Camera: Phoenix ICON (100° FOV) · 1240 by 1240 pixels · Phoenix ICON wide-field infant fundus image:
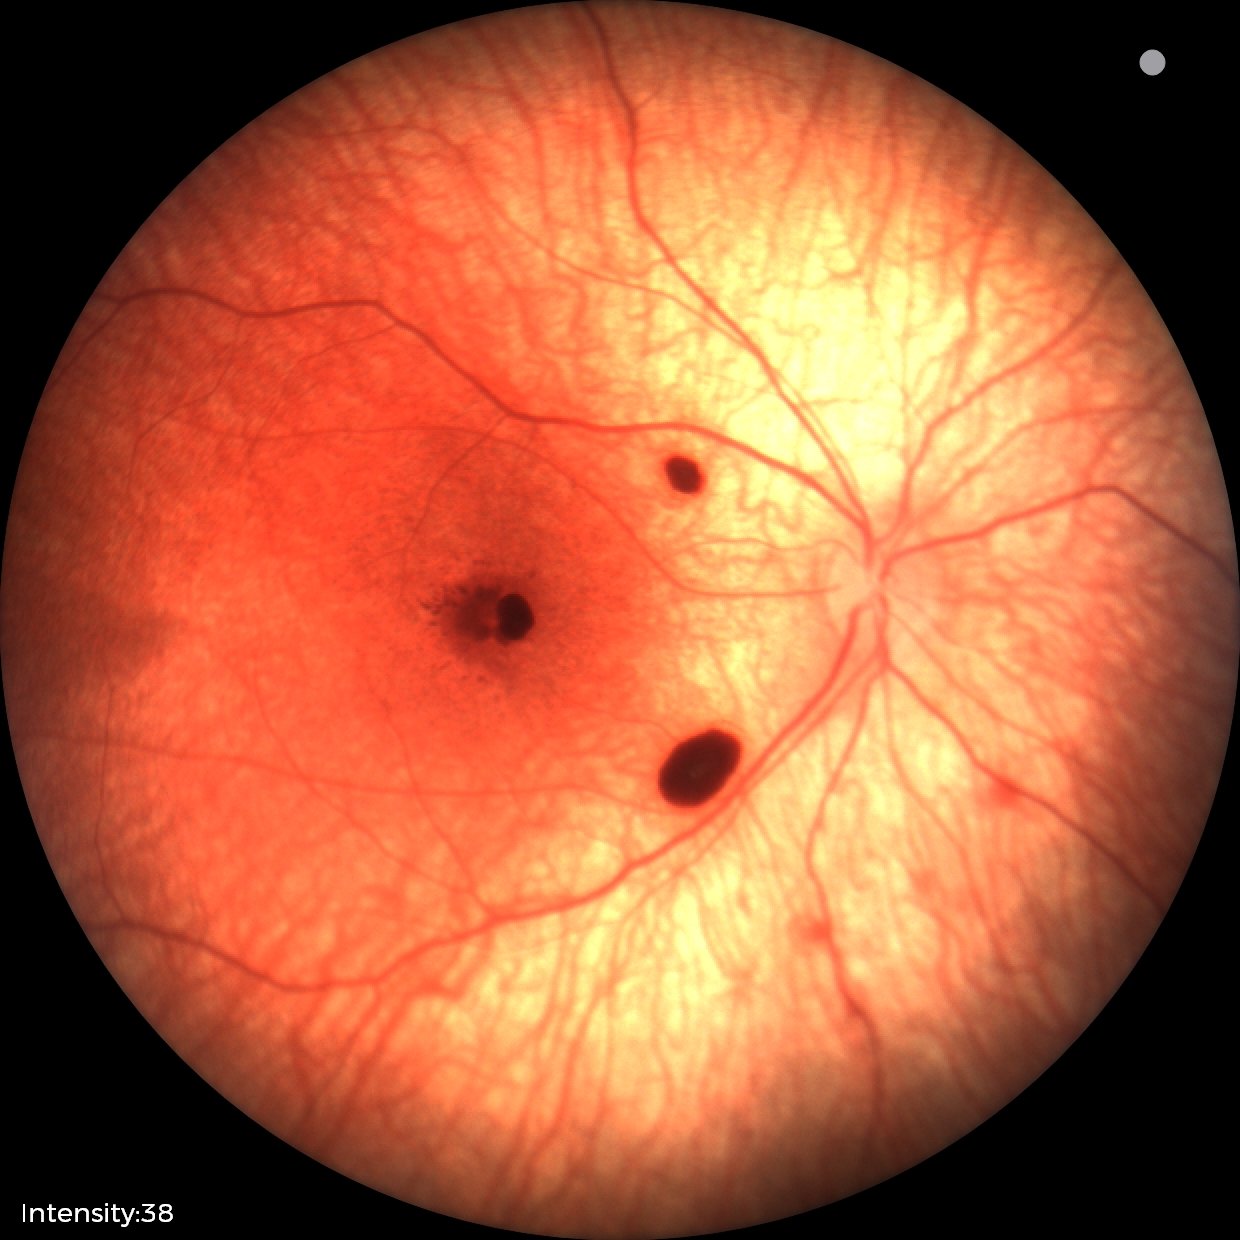

From an examination with diagnosis of retinal hemorrhages.